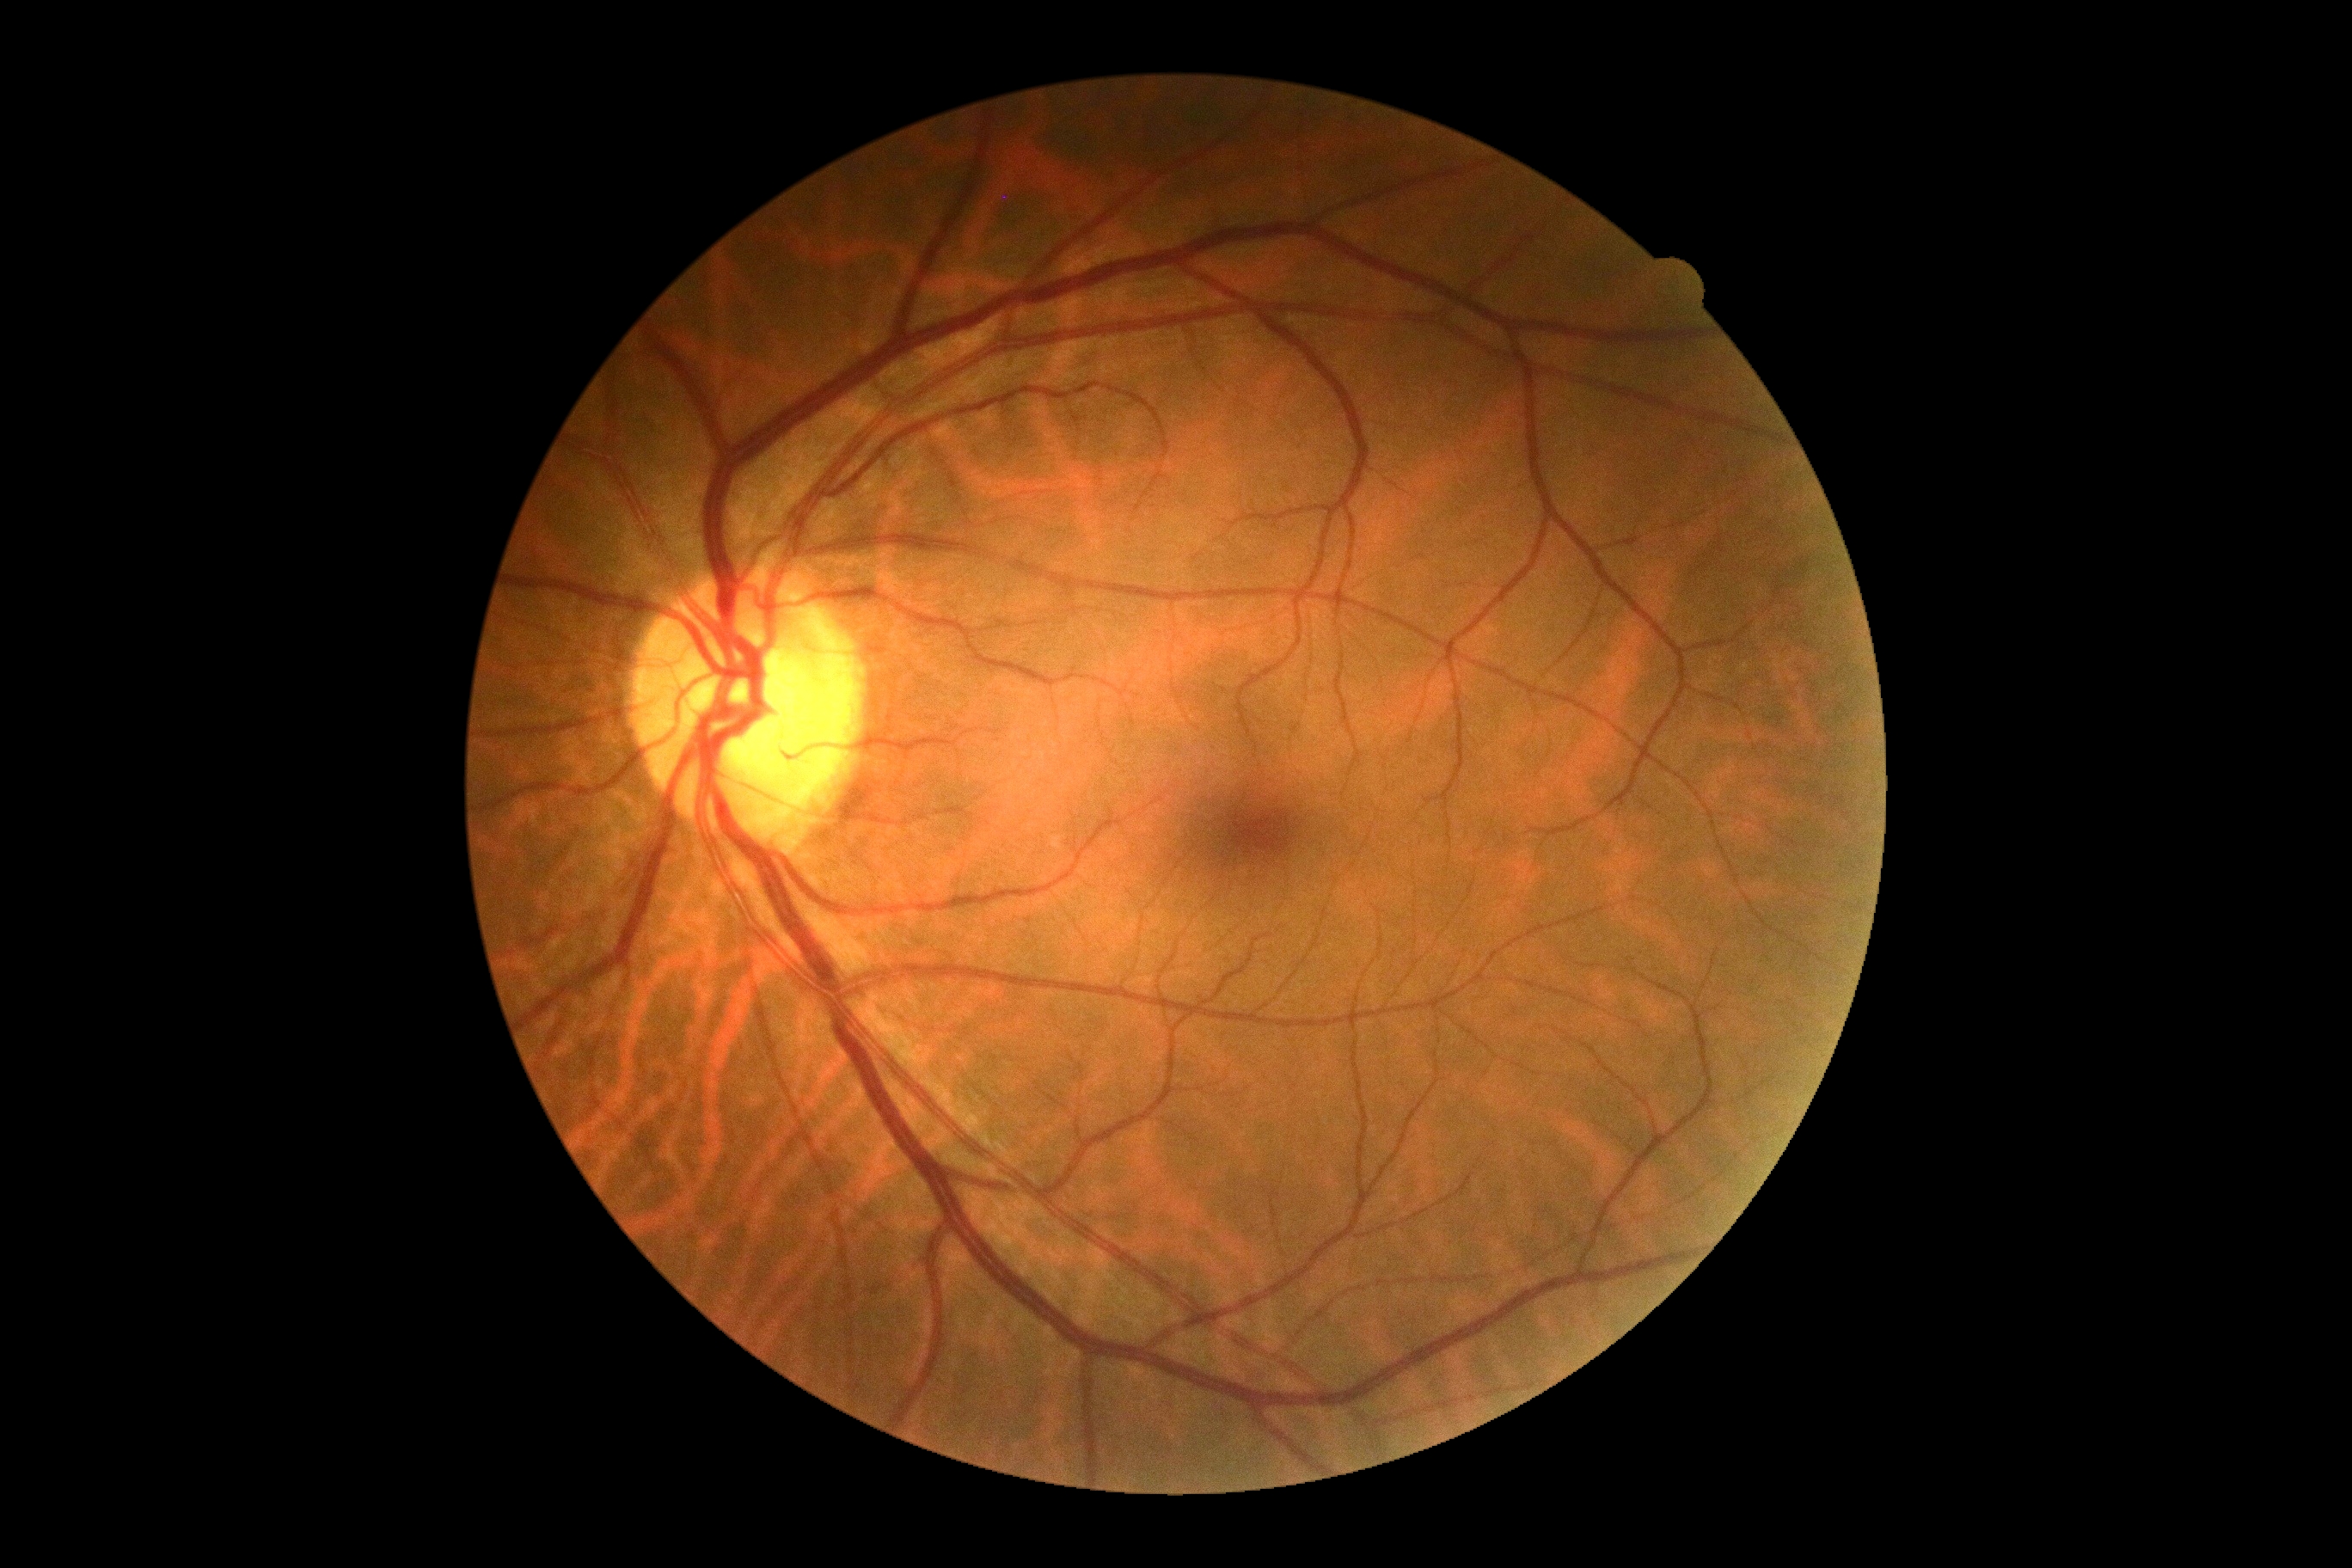 DR grade: 0.